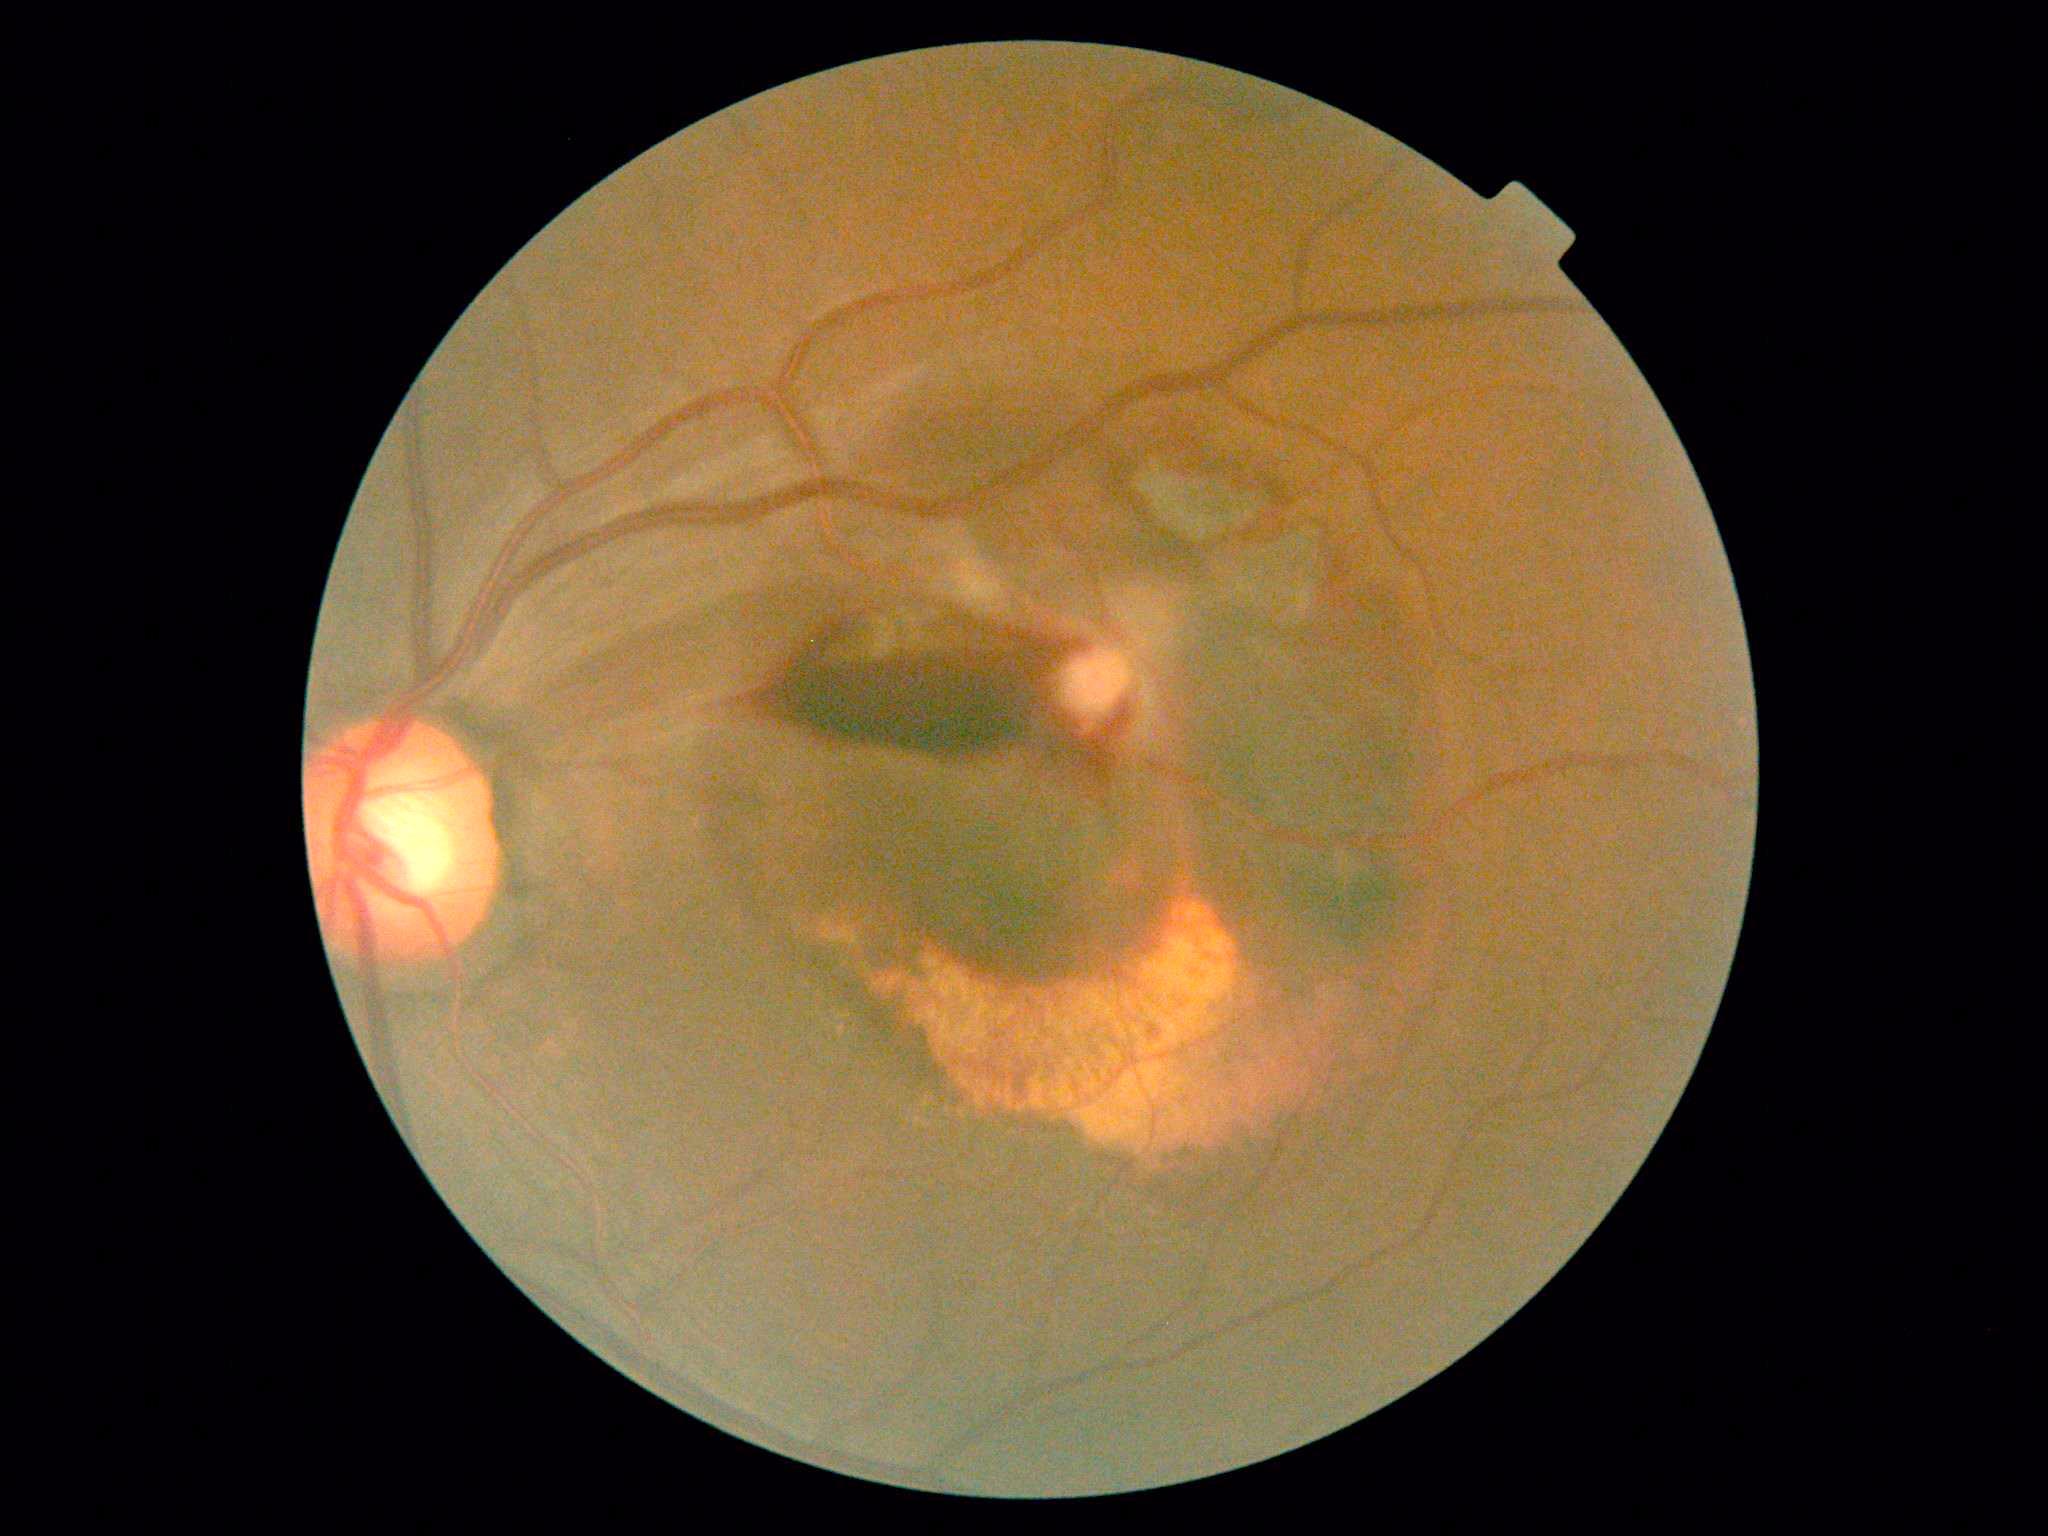

DR severity=4/4.